Image size 848x848 · graded on the modified Davis scale:
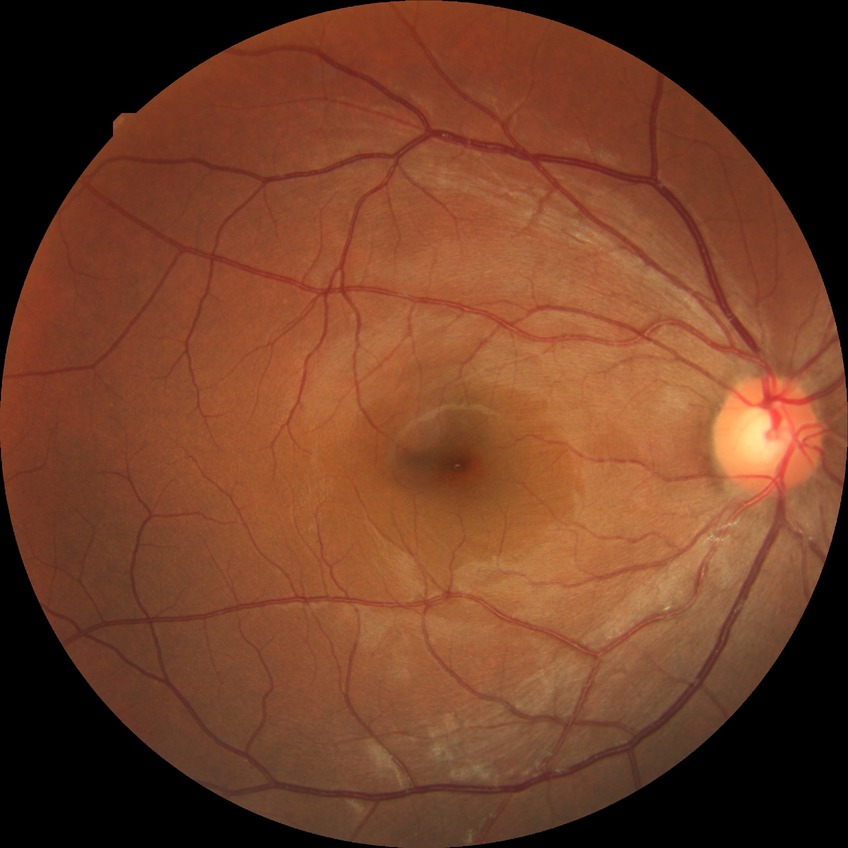

Davis grading = no diabetic retinopathy.